1932 by 1932 pixels — 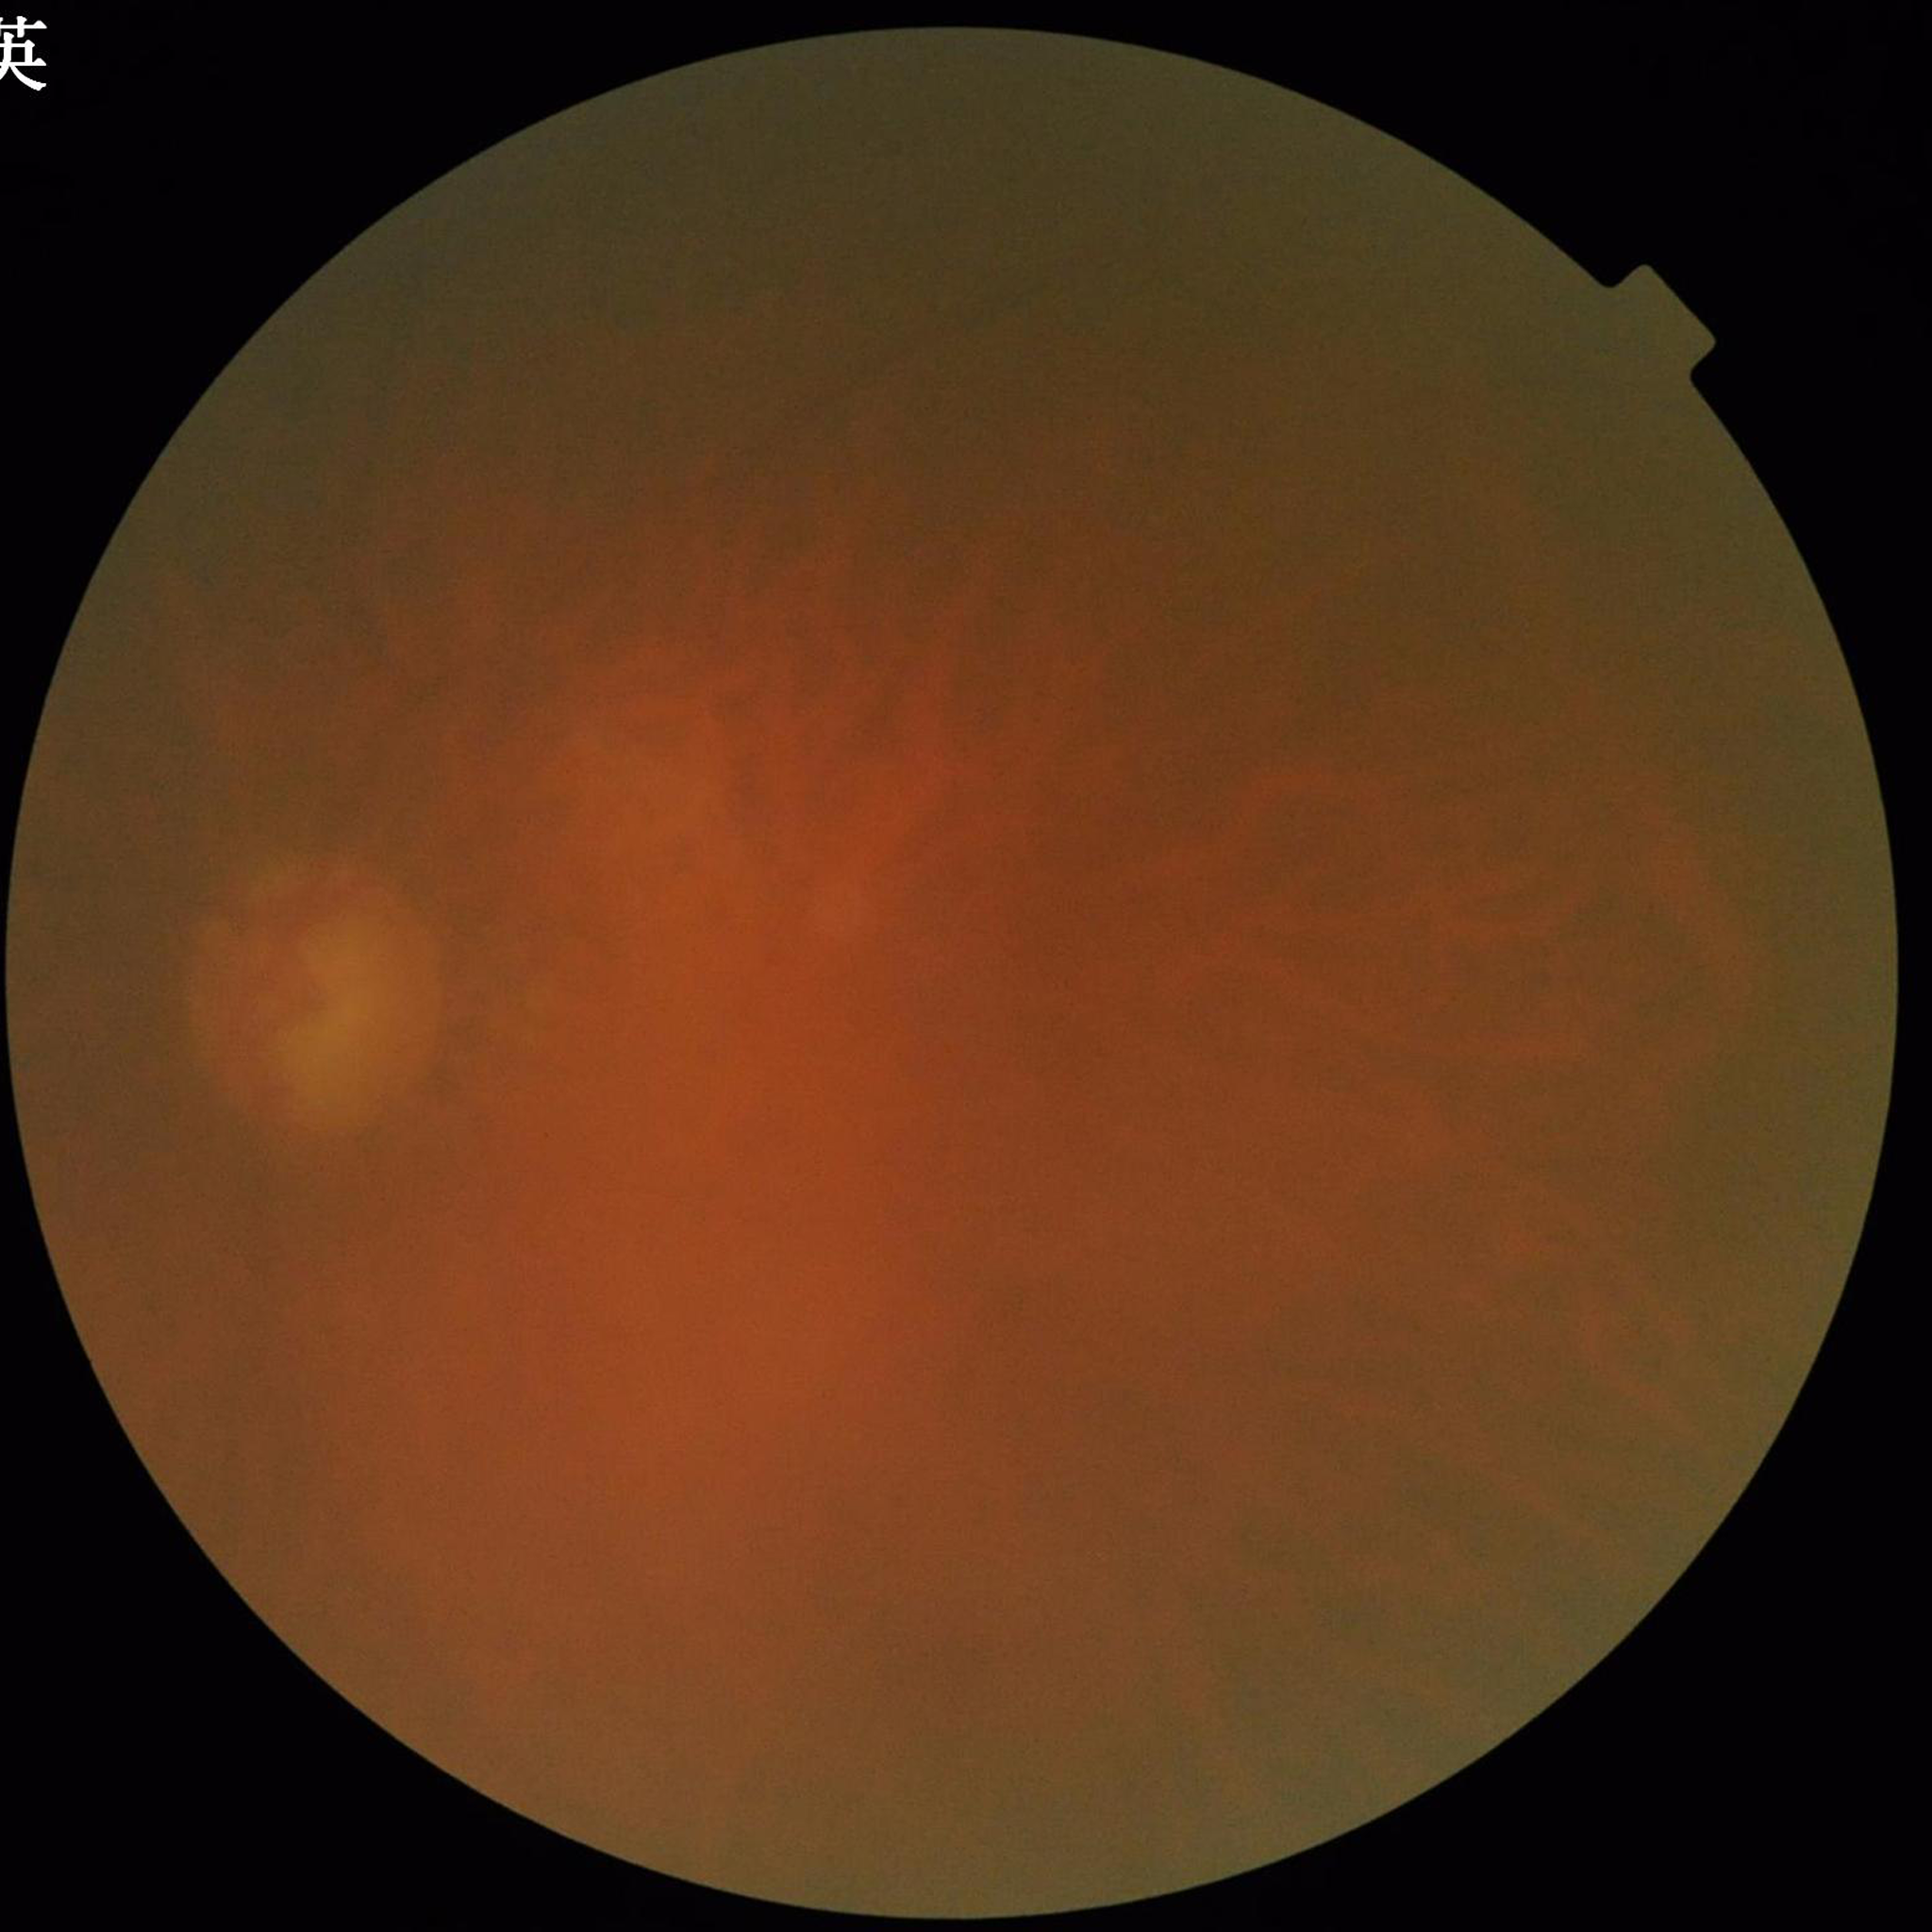
Impression: glaucoma
Quality: issues noted — blur, low contrast, illumination/color distortion